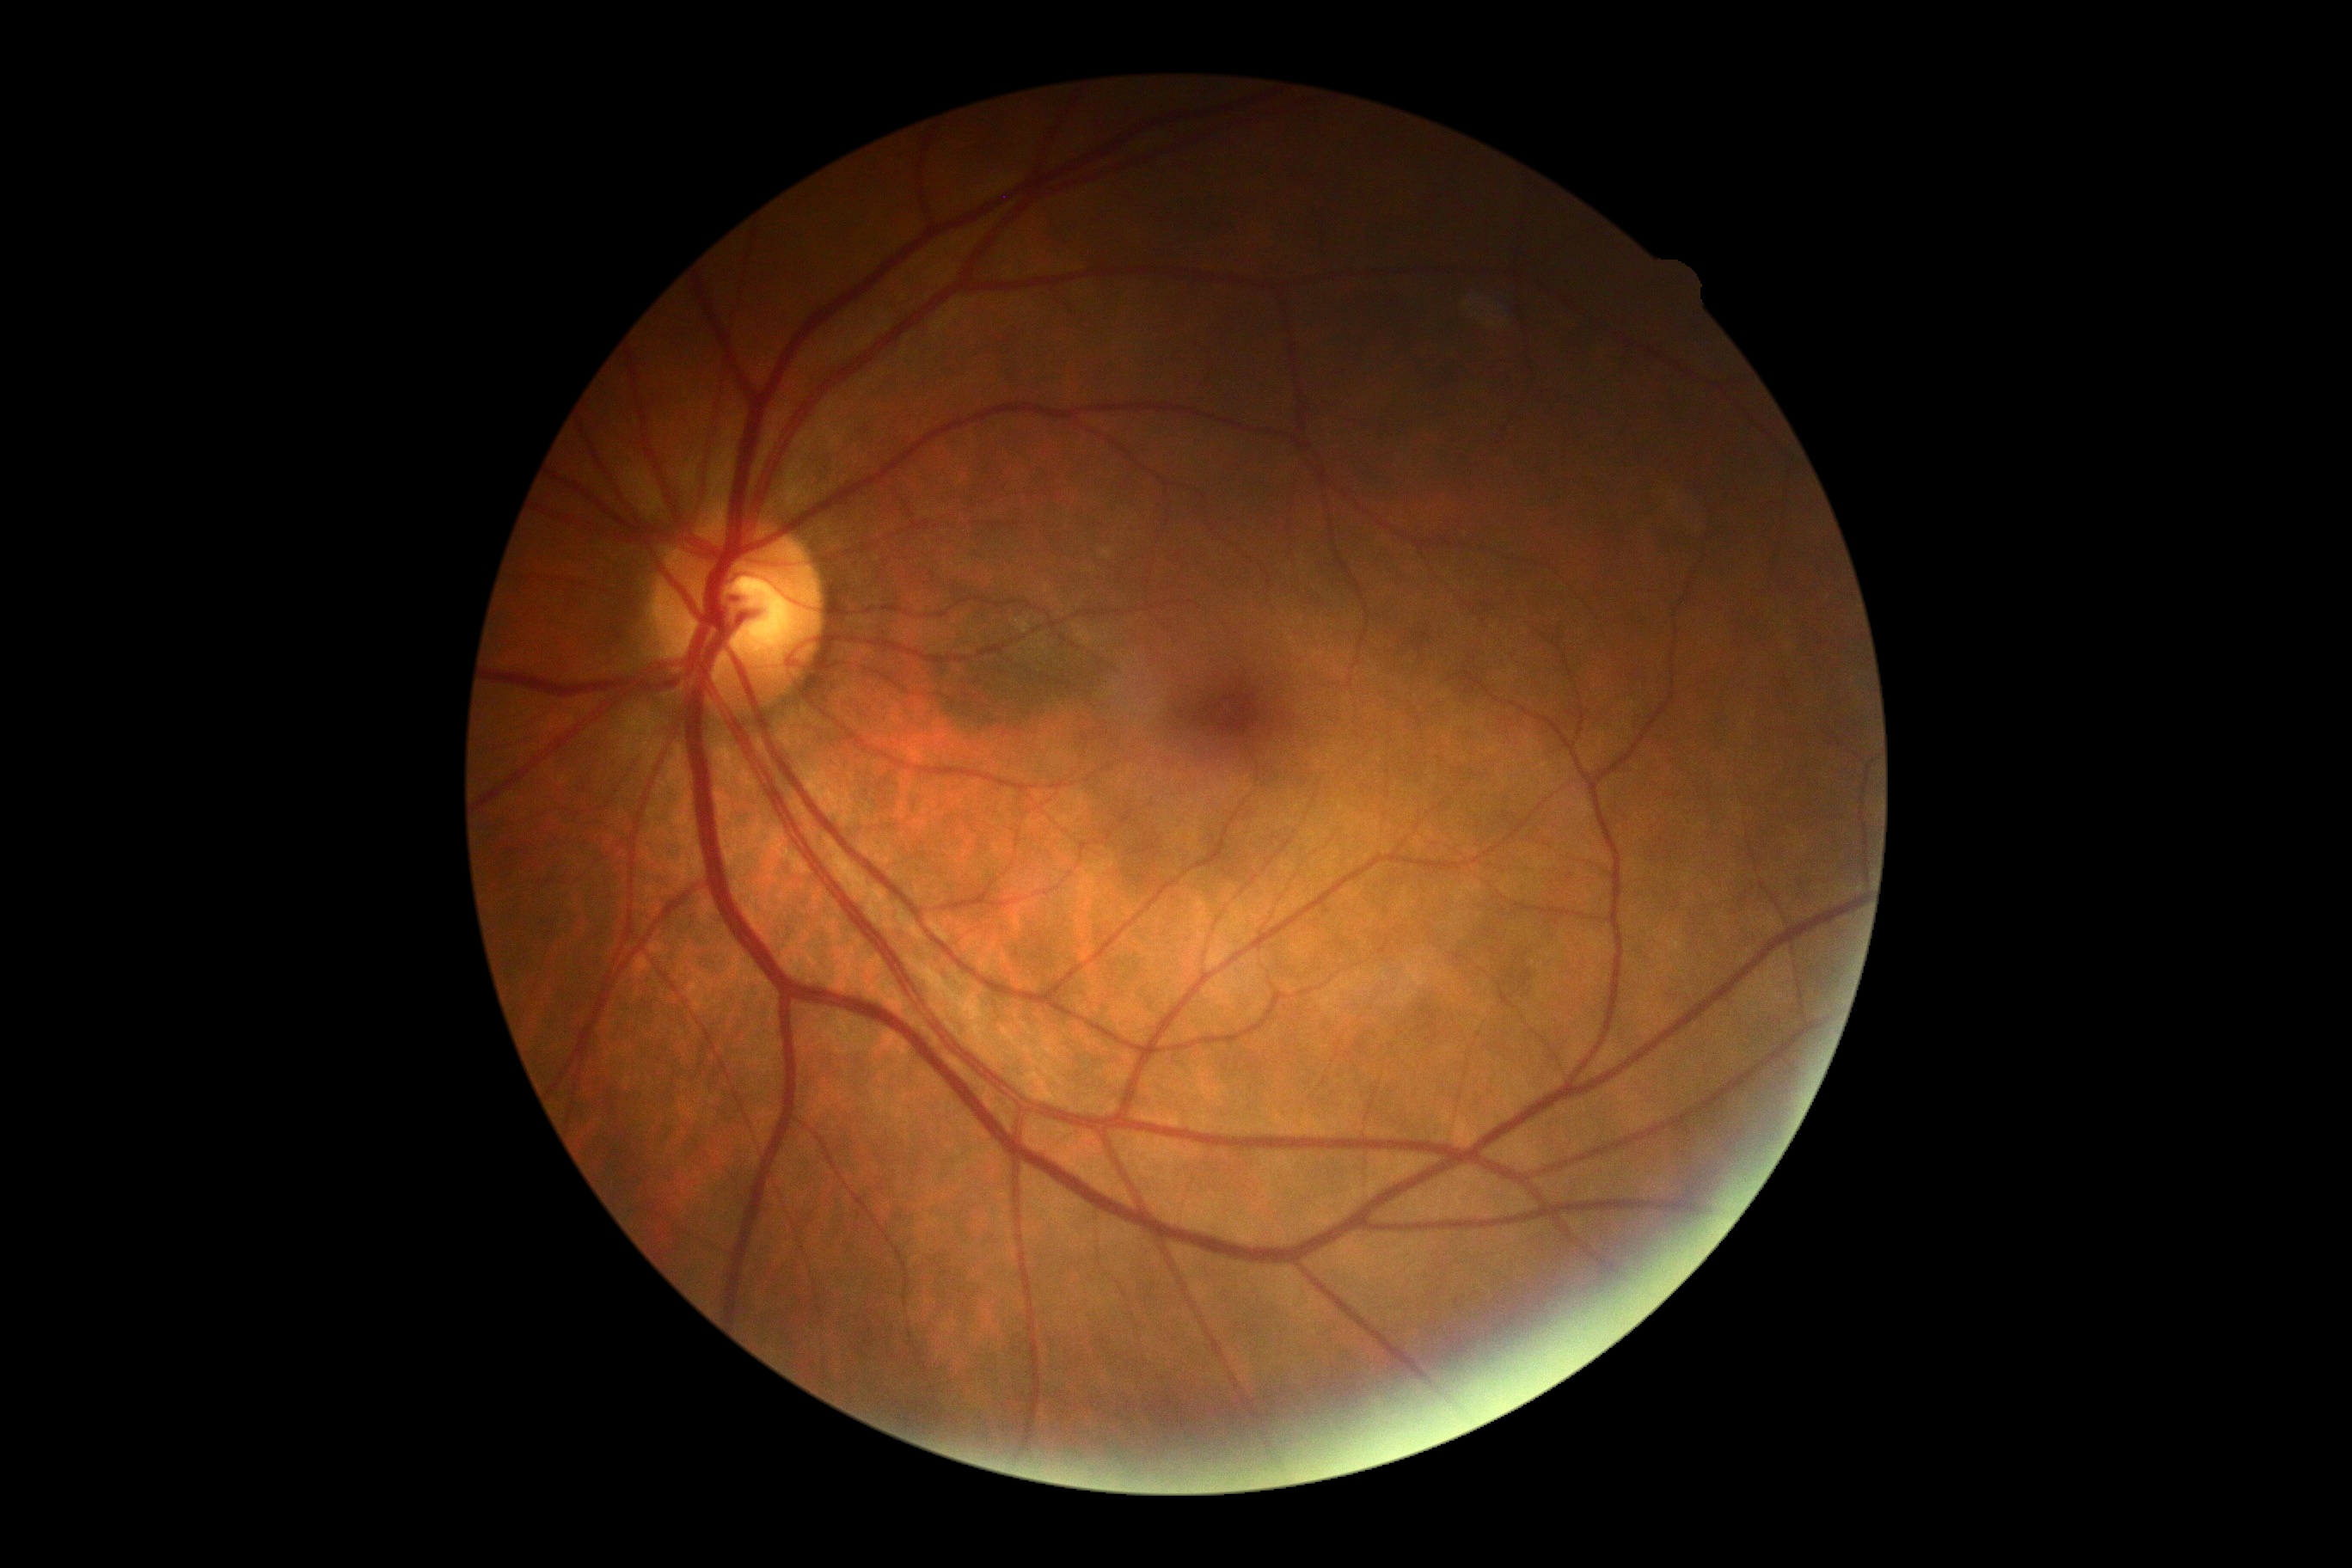
DR impression@no signs of DR; DR stage@0.